Image size 1924x1556.
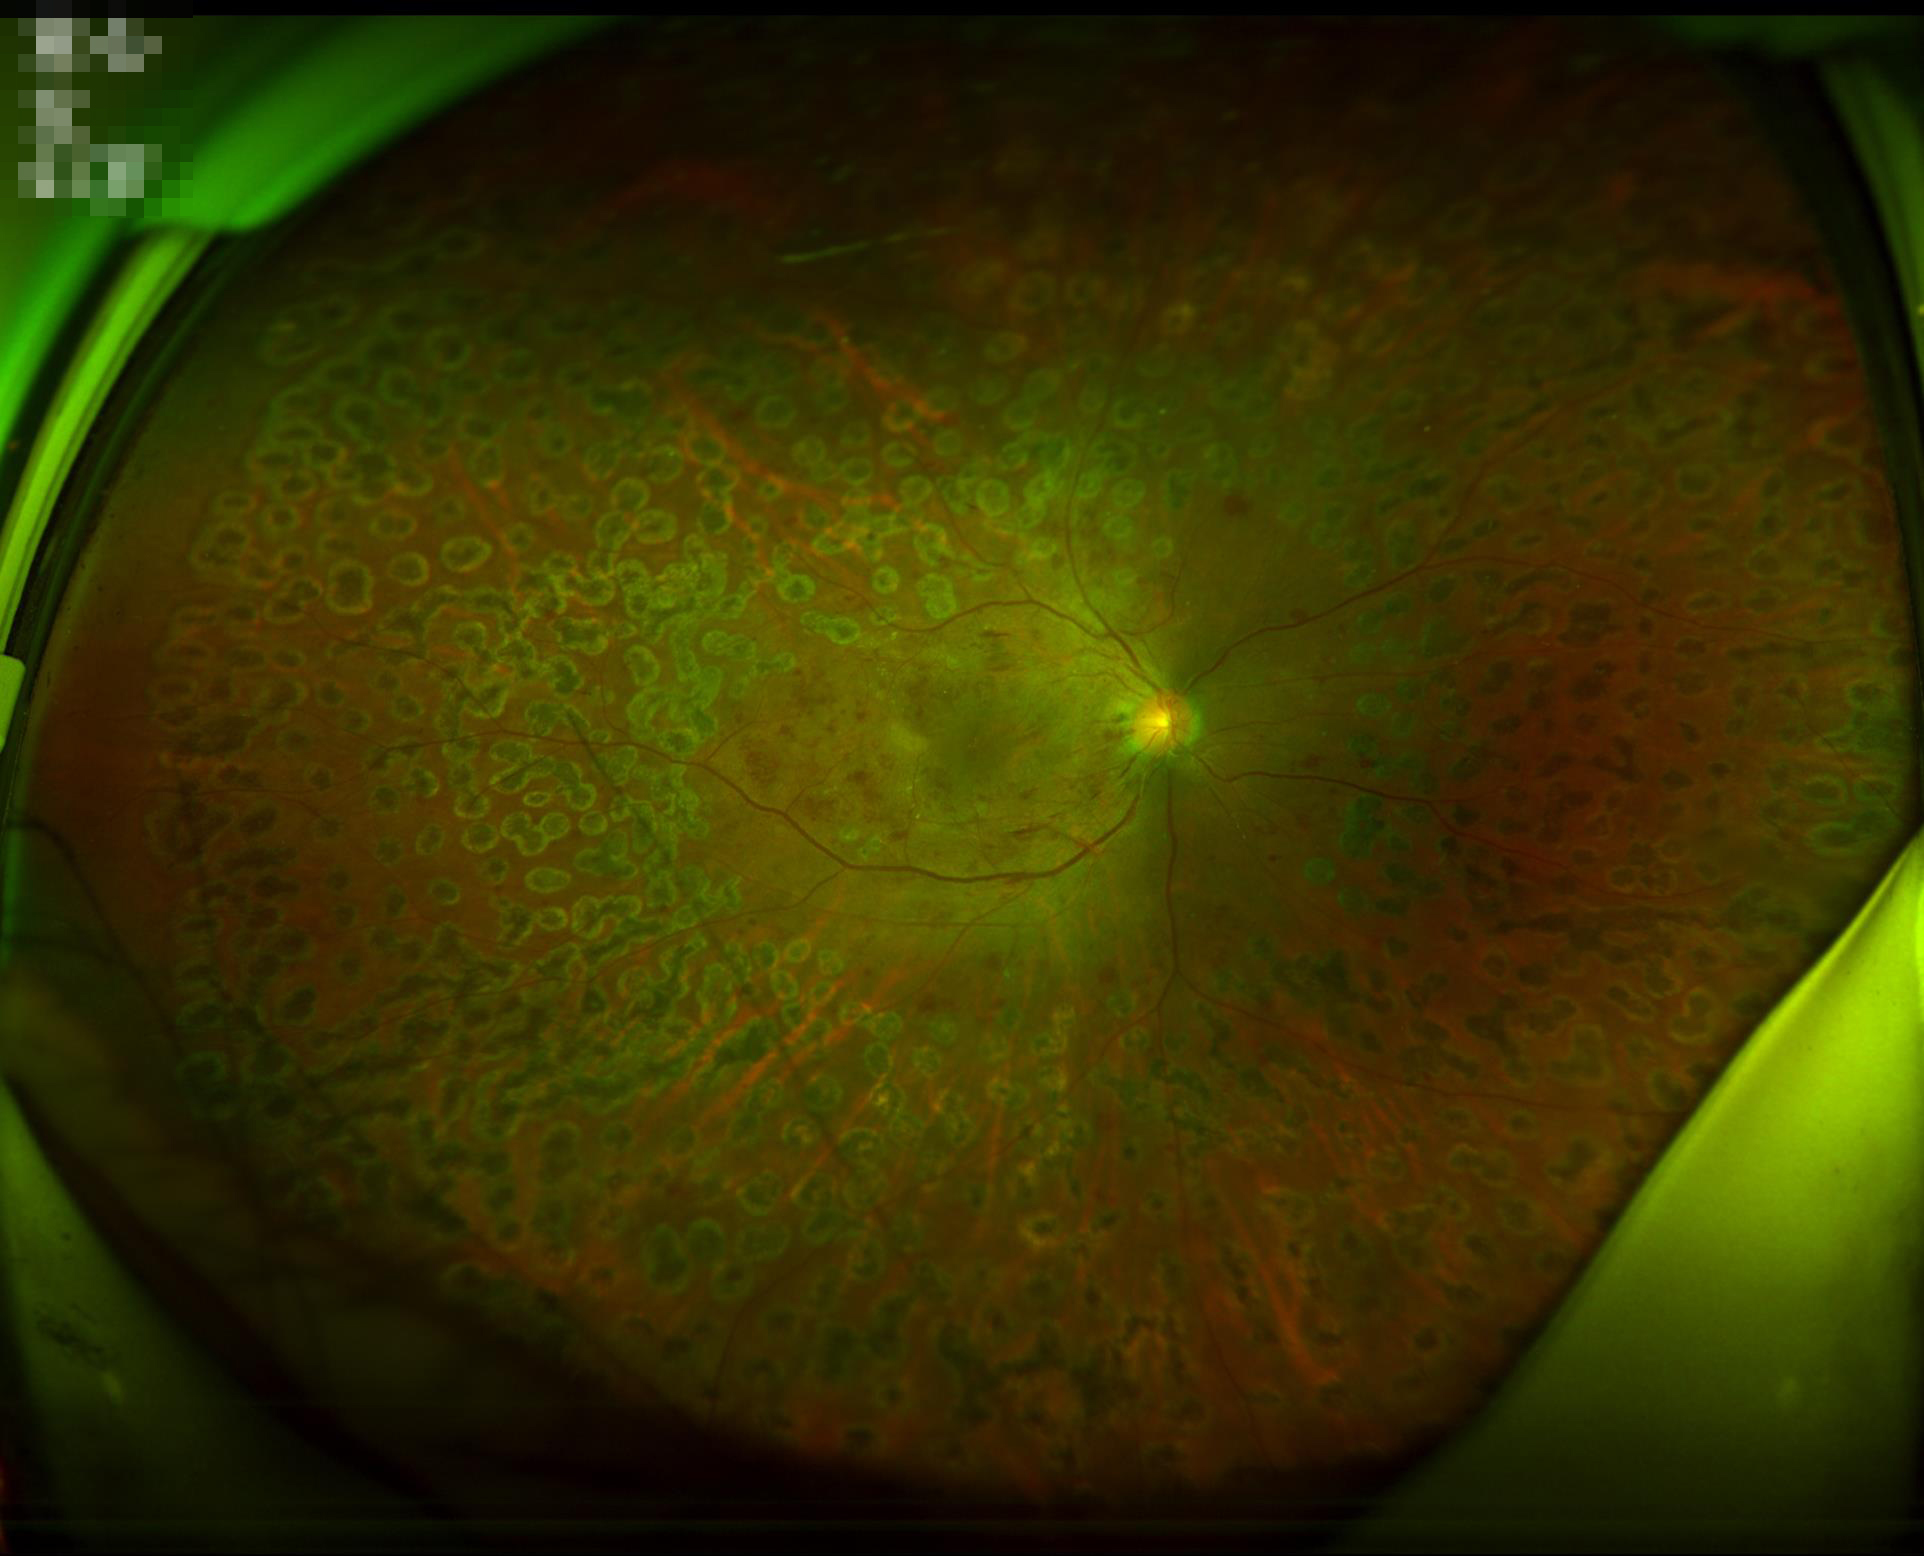 Illumination is even. Adequate contrast for distinguishing structures. Image quality is adequate for diagnostic use.